45-degree field of view: 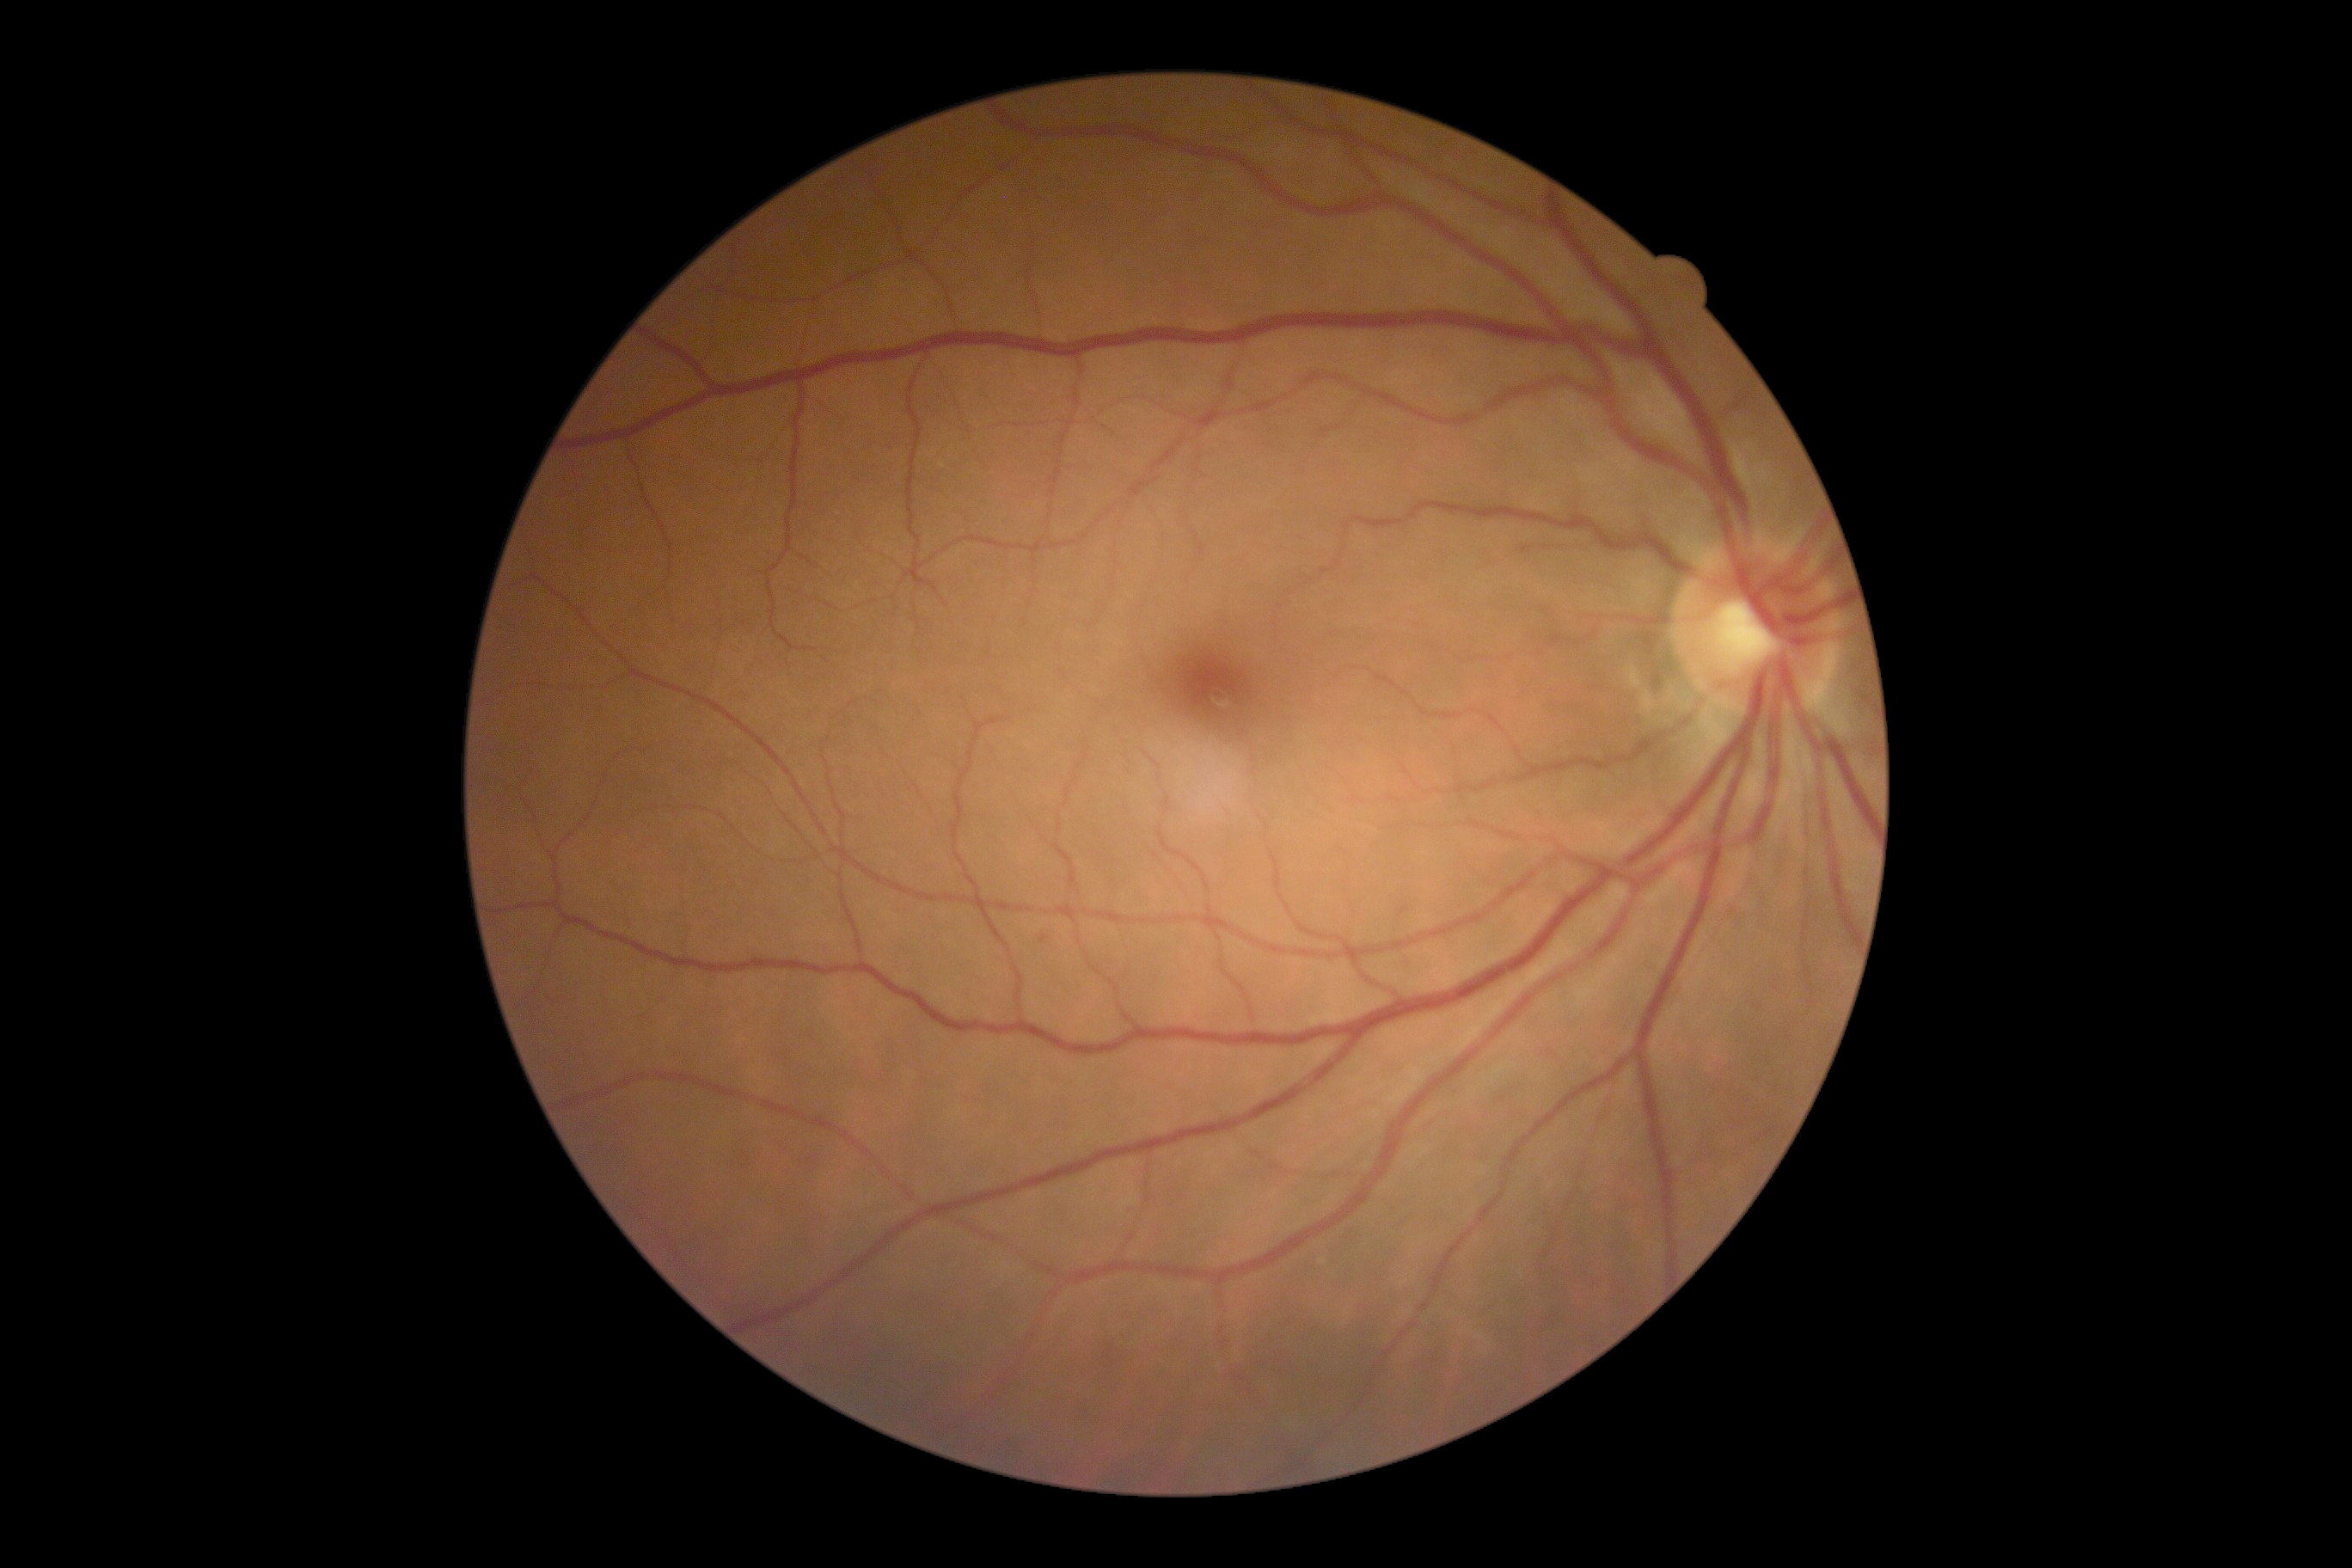
Retinopathy grade: 1 (mild NPDR).